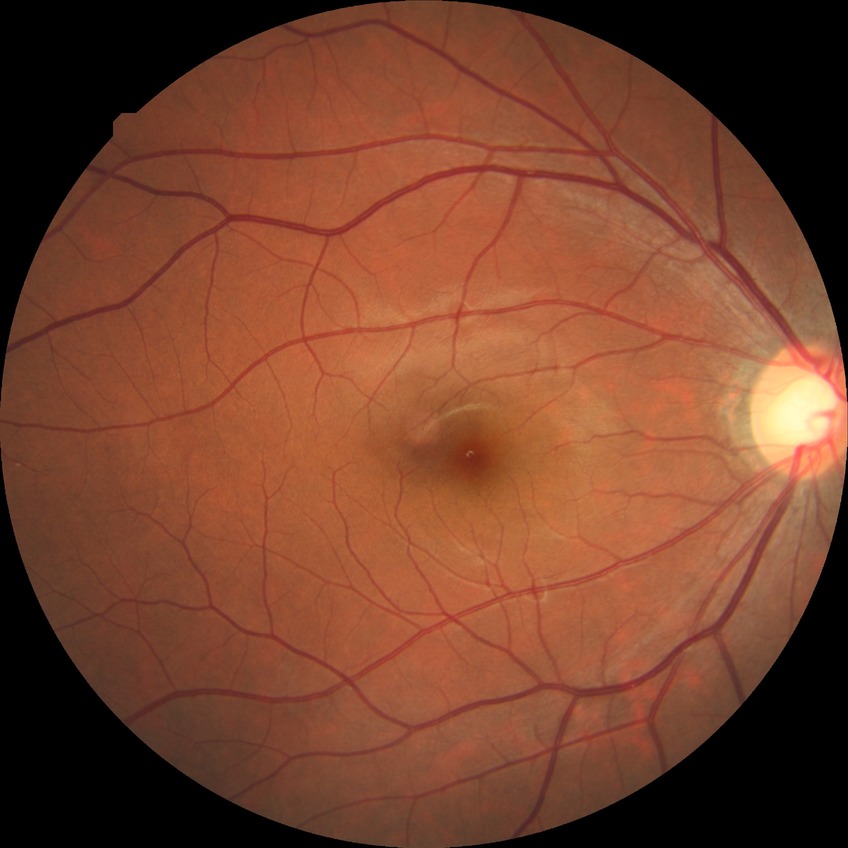
* diabetic retinopathy (DR): simple diabetic retinopathy (SDR)